Davis DR grading; CFP
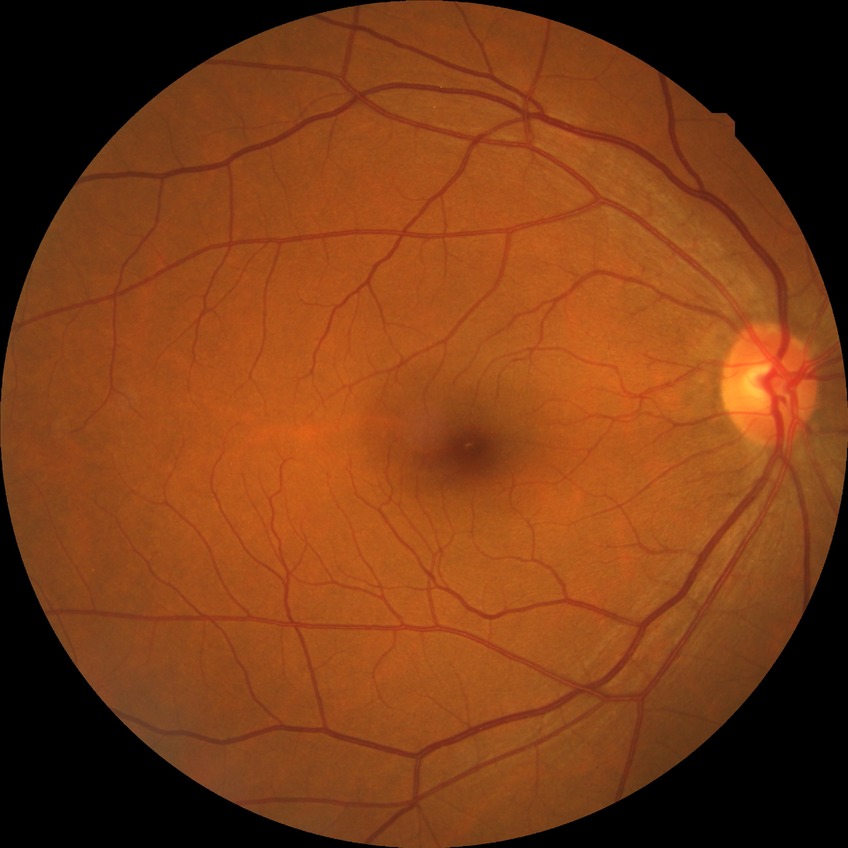 Retinopathy stage is no diabetic retinopathy.